848x848px. Modified Davis classification:
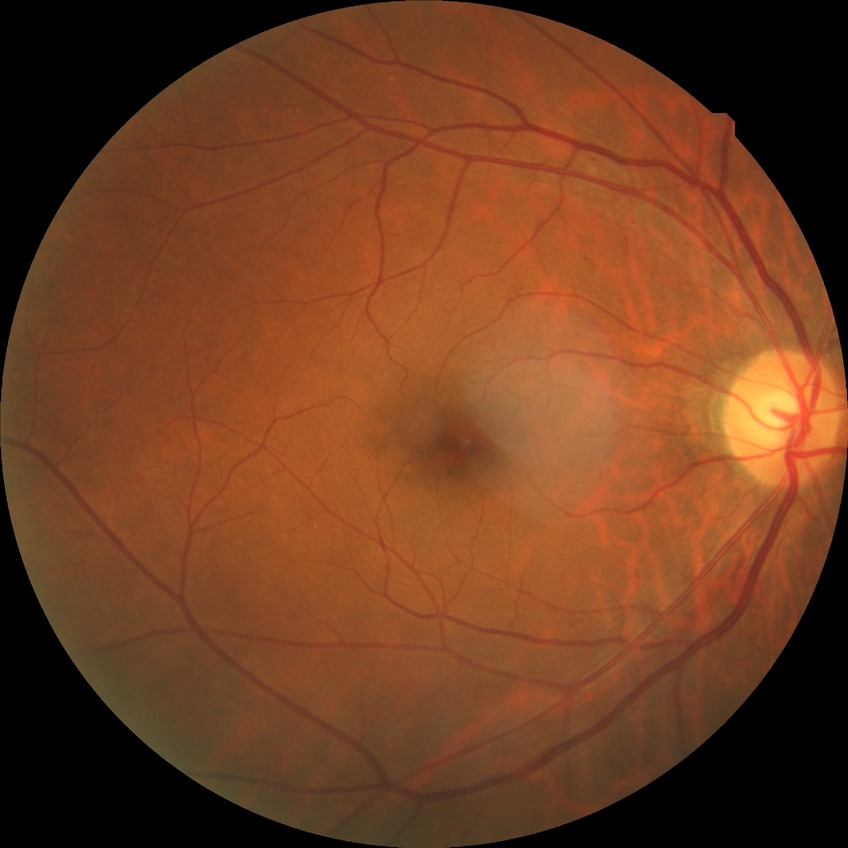
Modified Davis grade: SDR. Disease class: non-proliferative diabetic retinopathy.